Color fundus photograph · nonmydriatic — 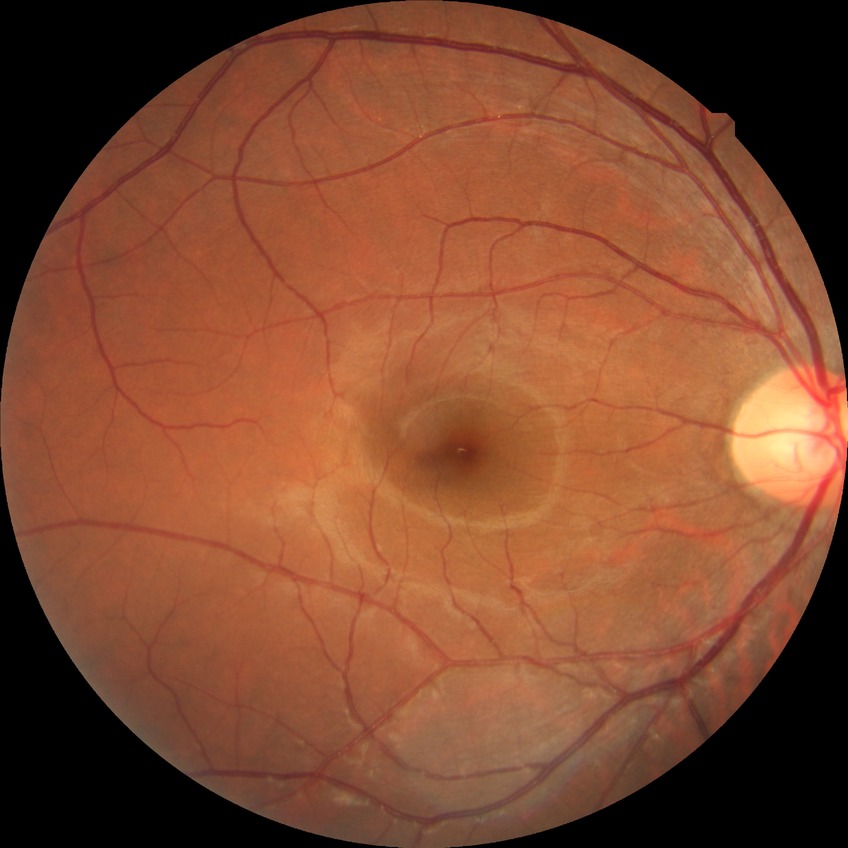

Diabetic retinopathy (DR) is NDR (no diabetic retinopathy).